2212x1659px · 45° FOV — 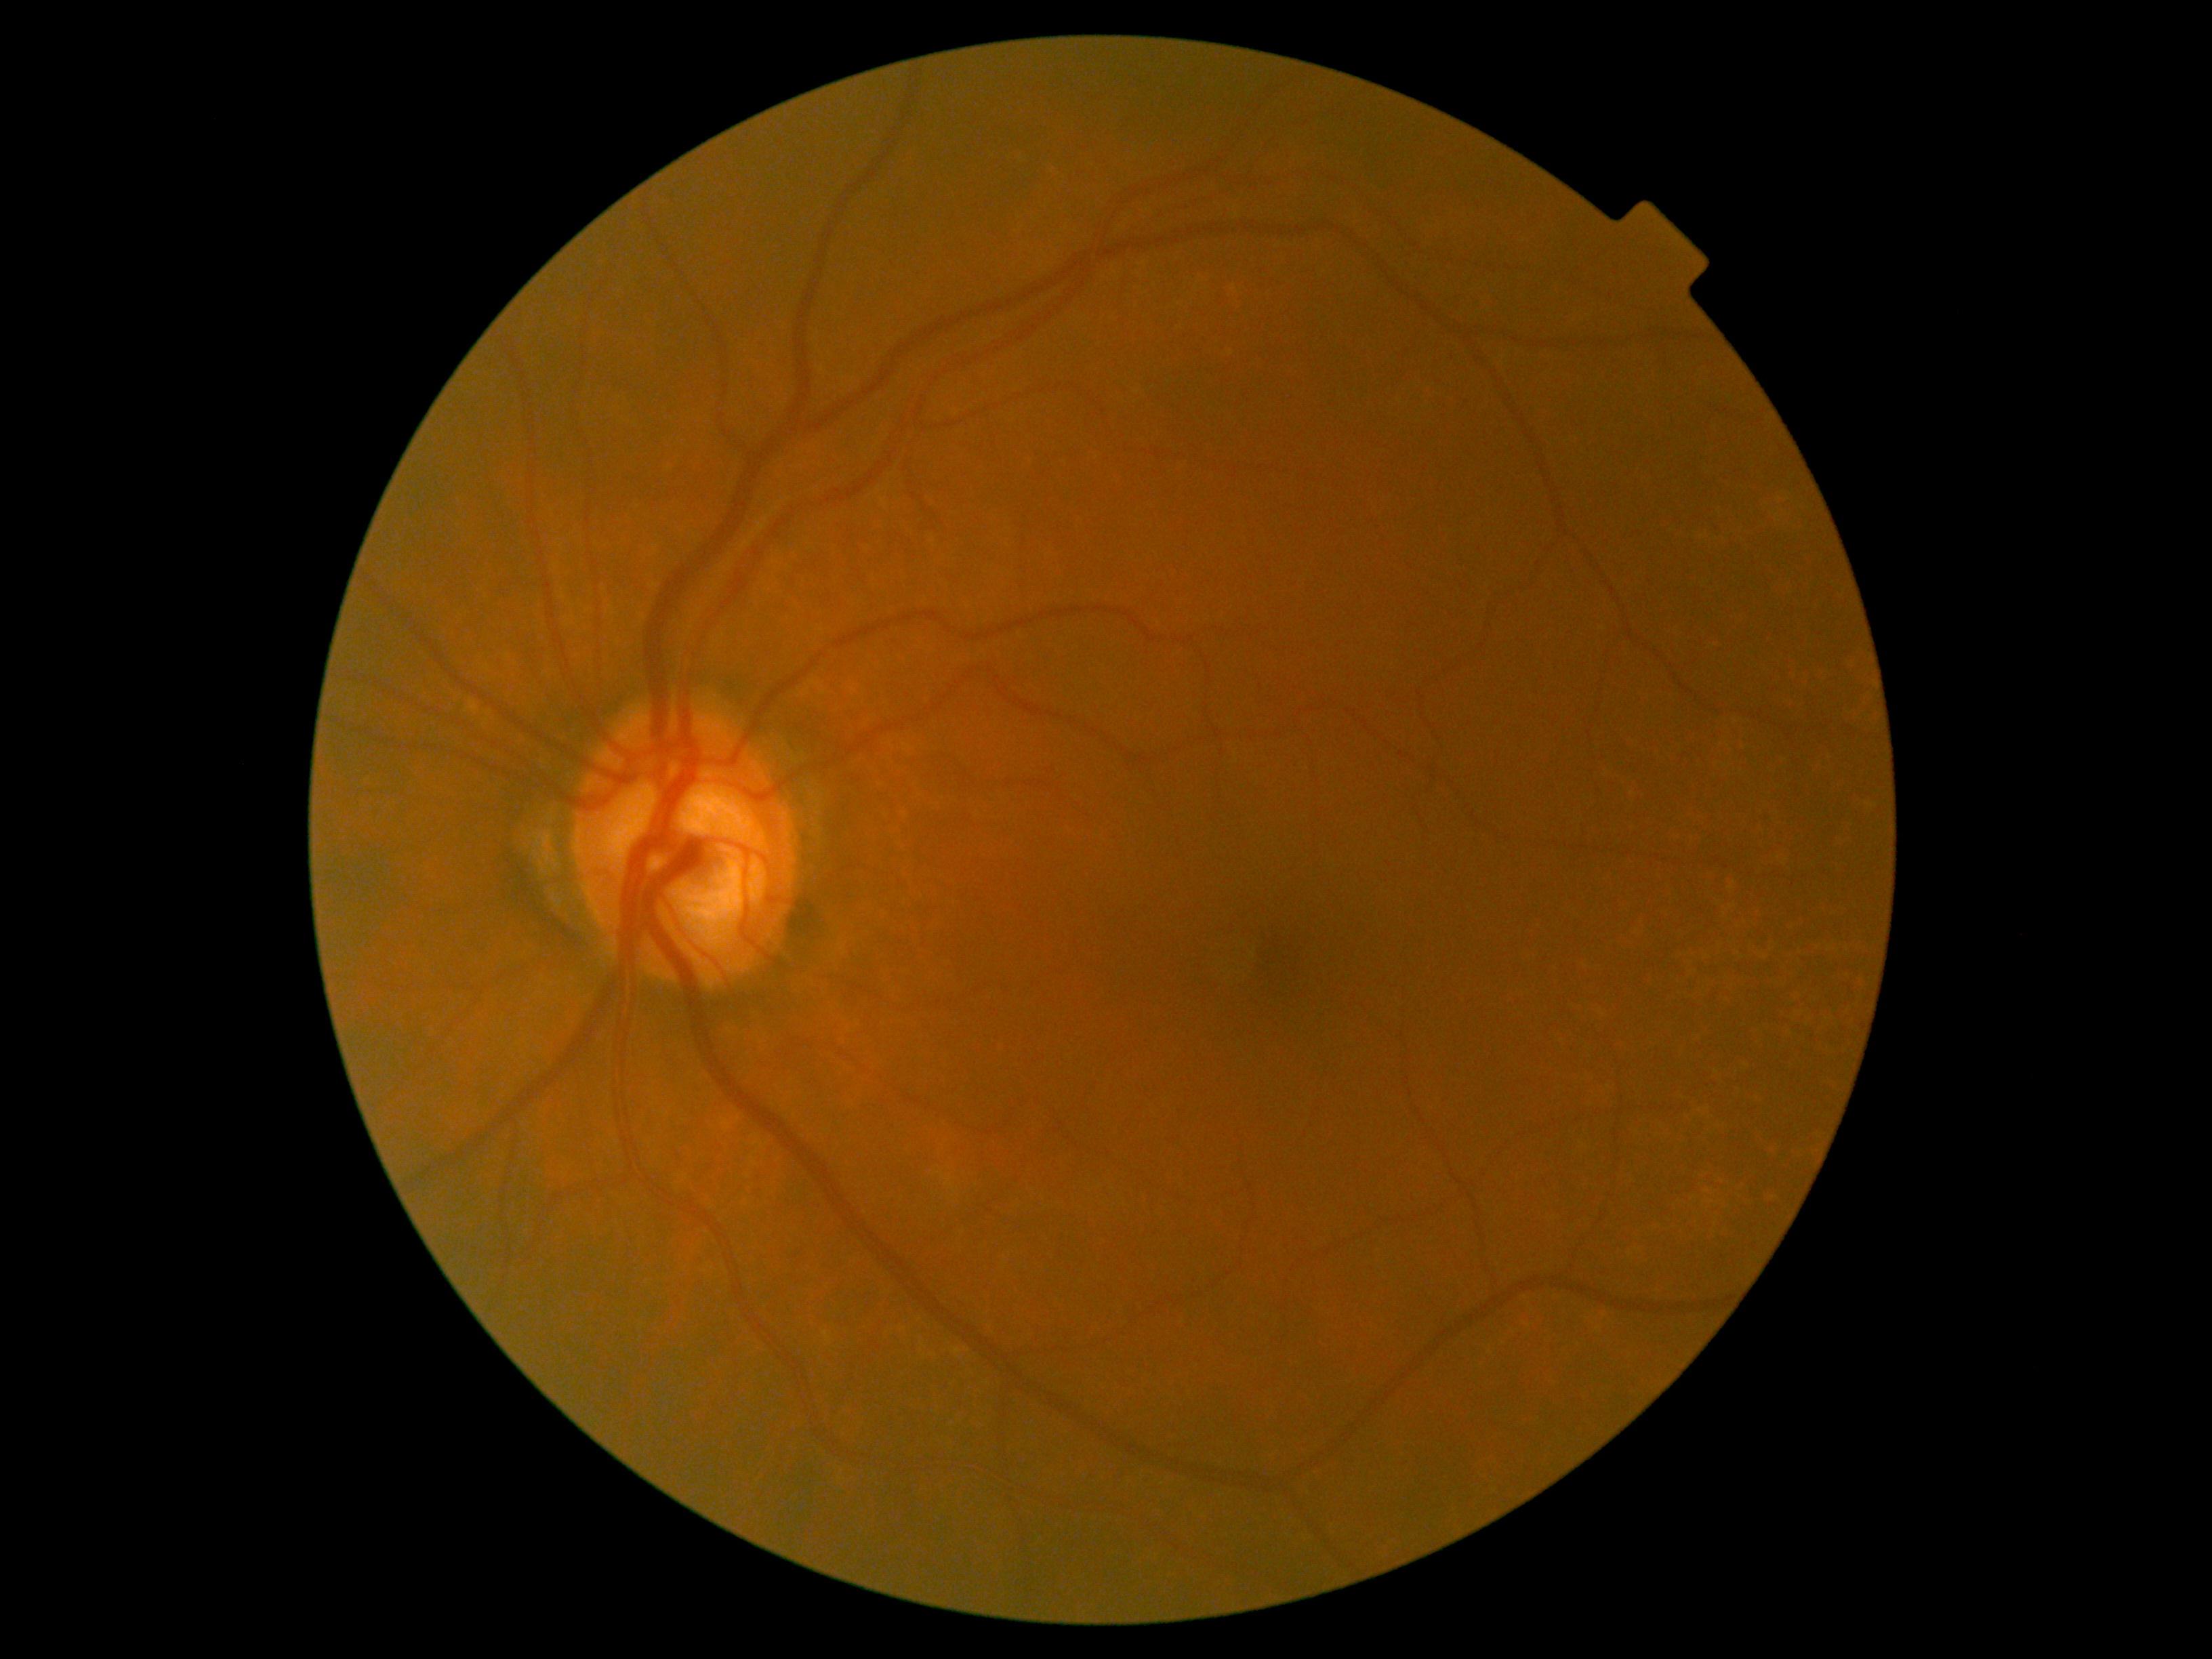
No DR findings. Diabetic retinopathy grade is 0.